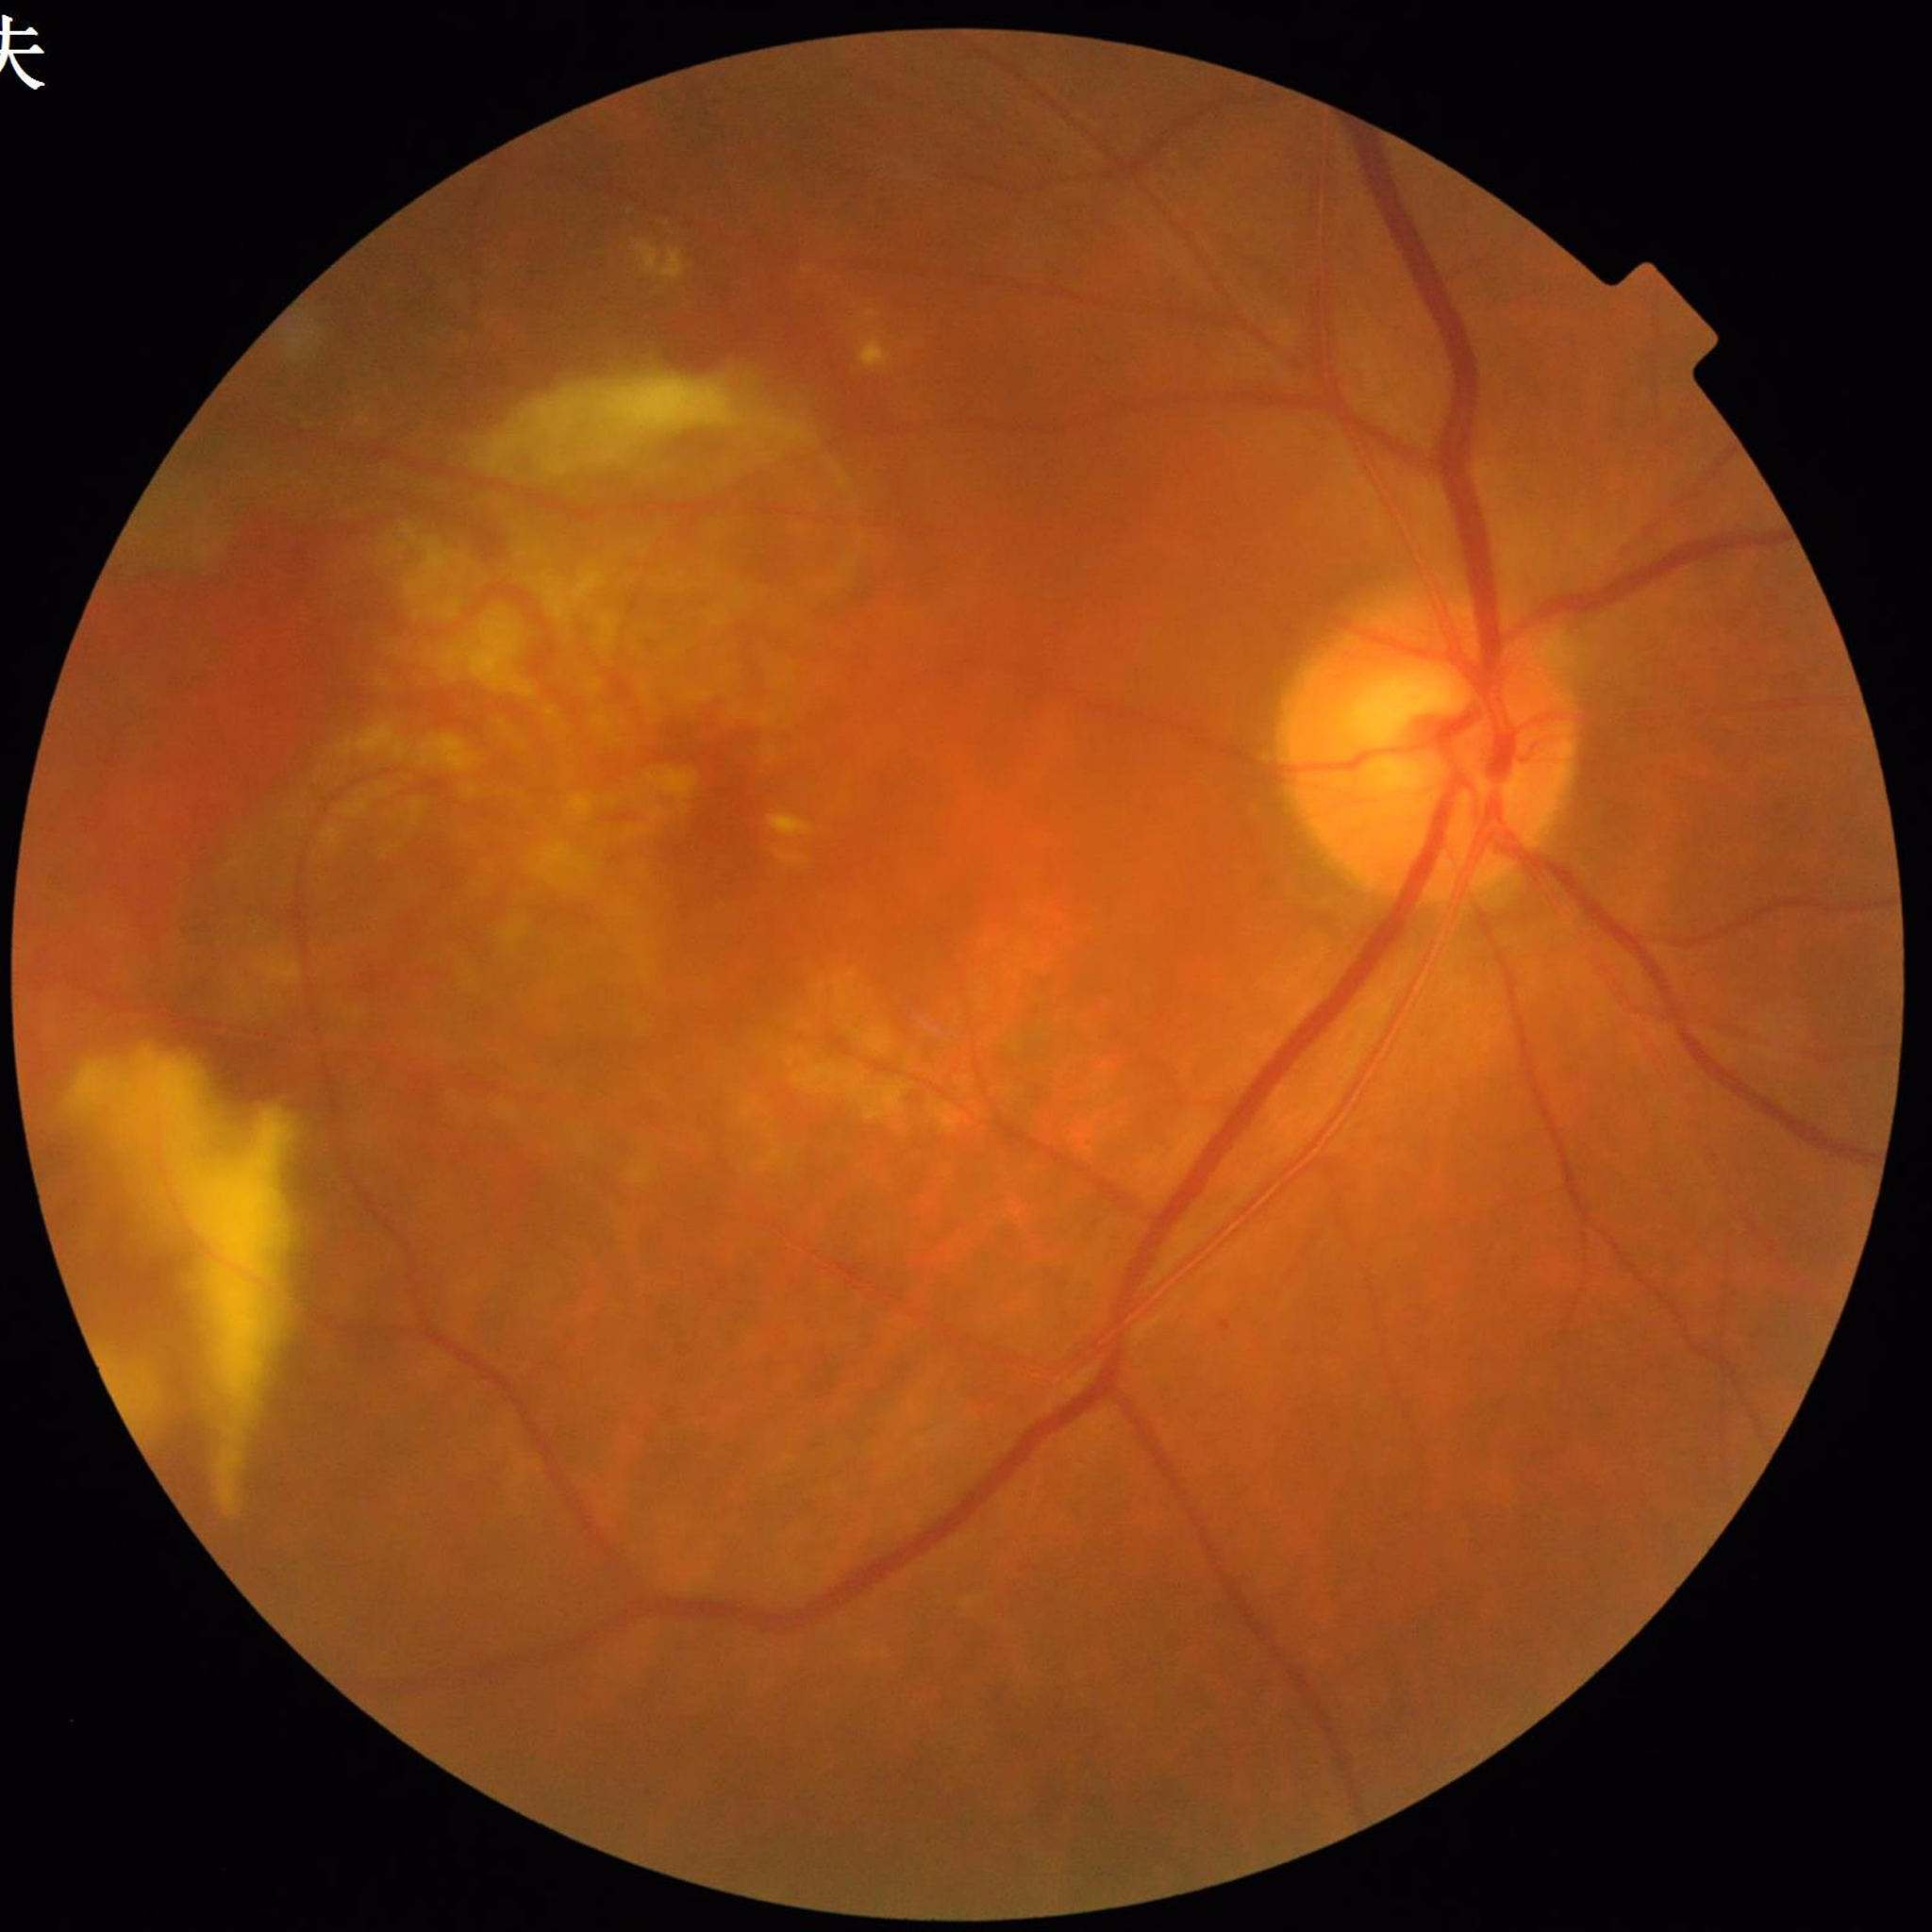

Eye affected by age-related macular degeneration.